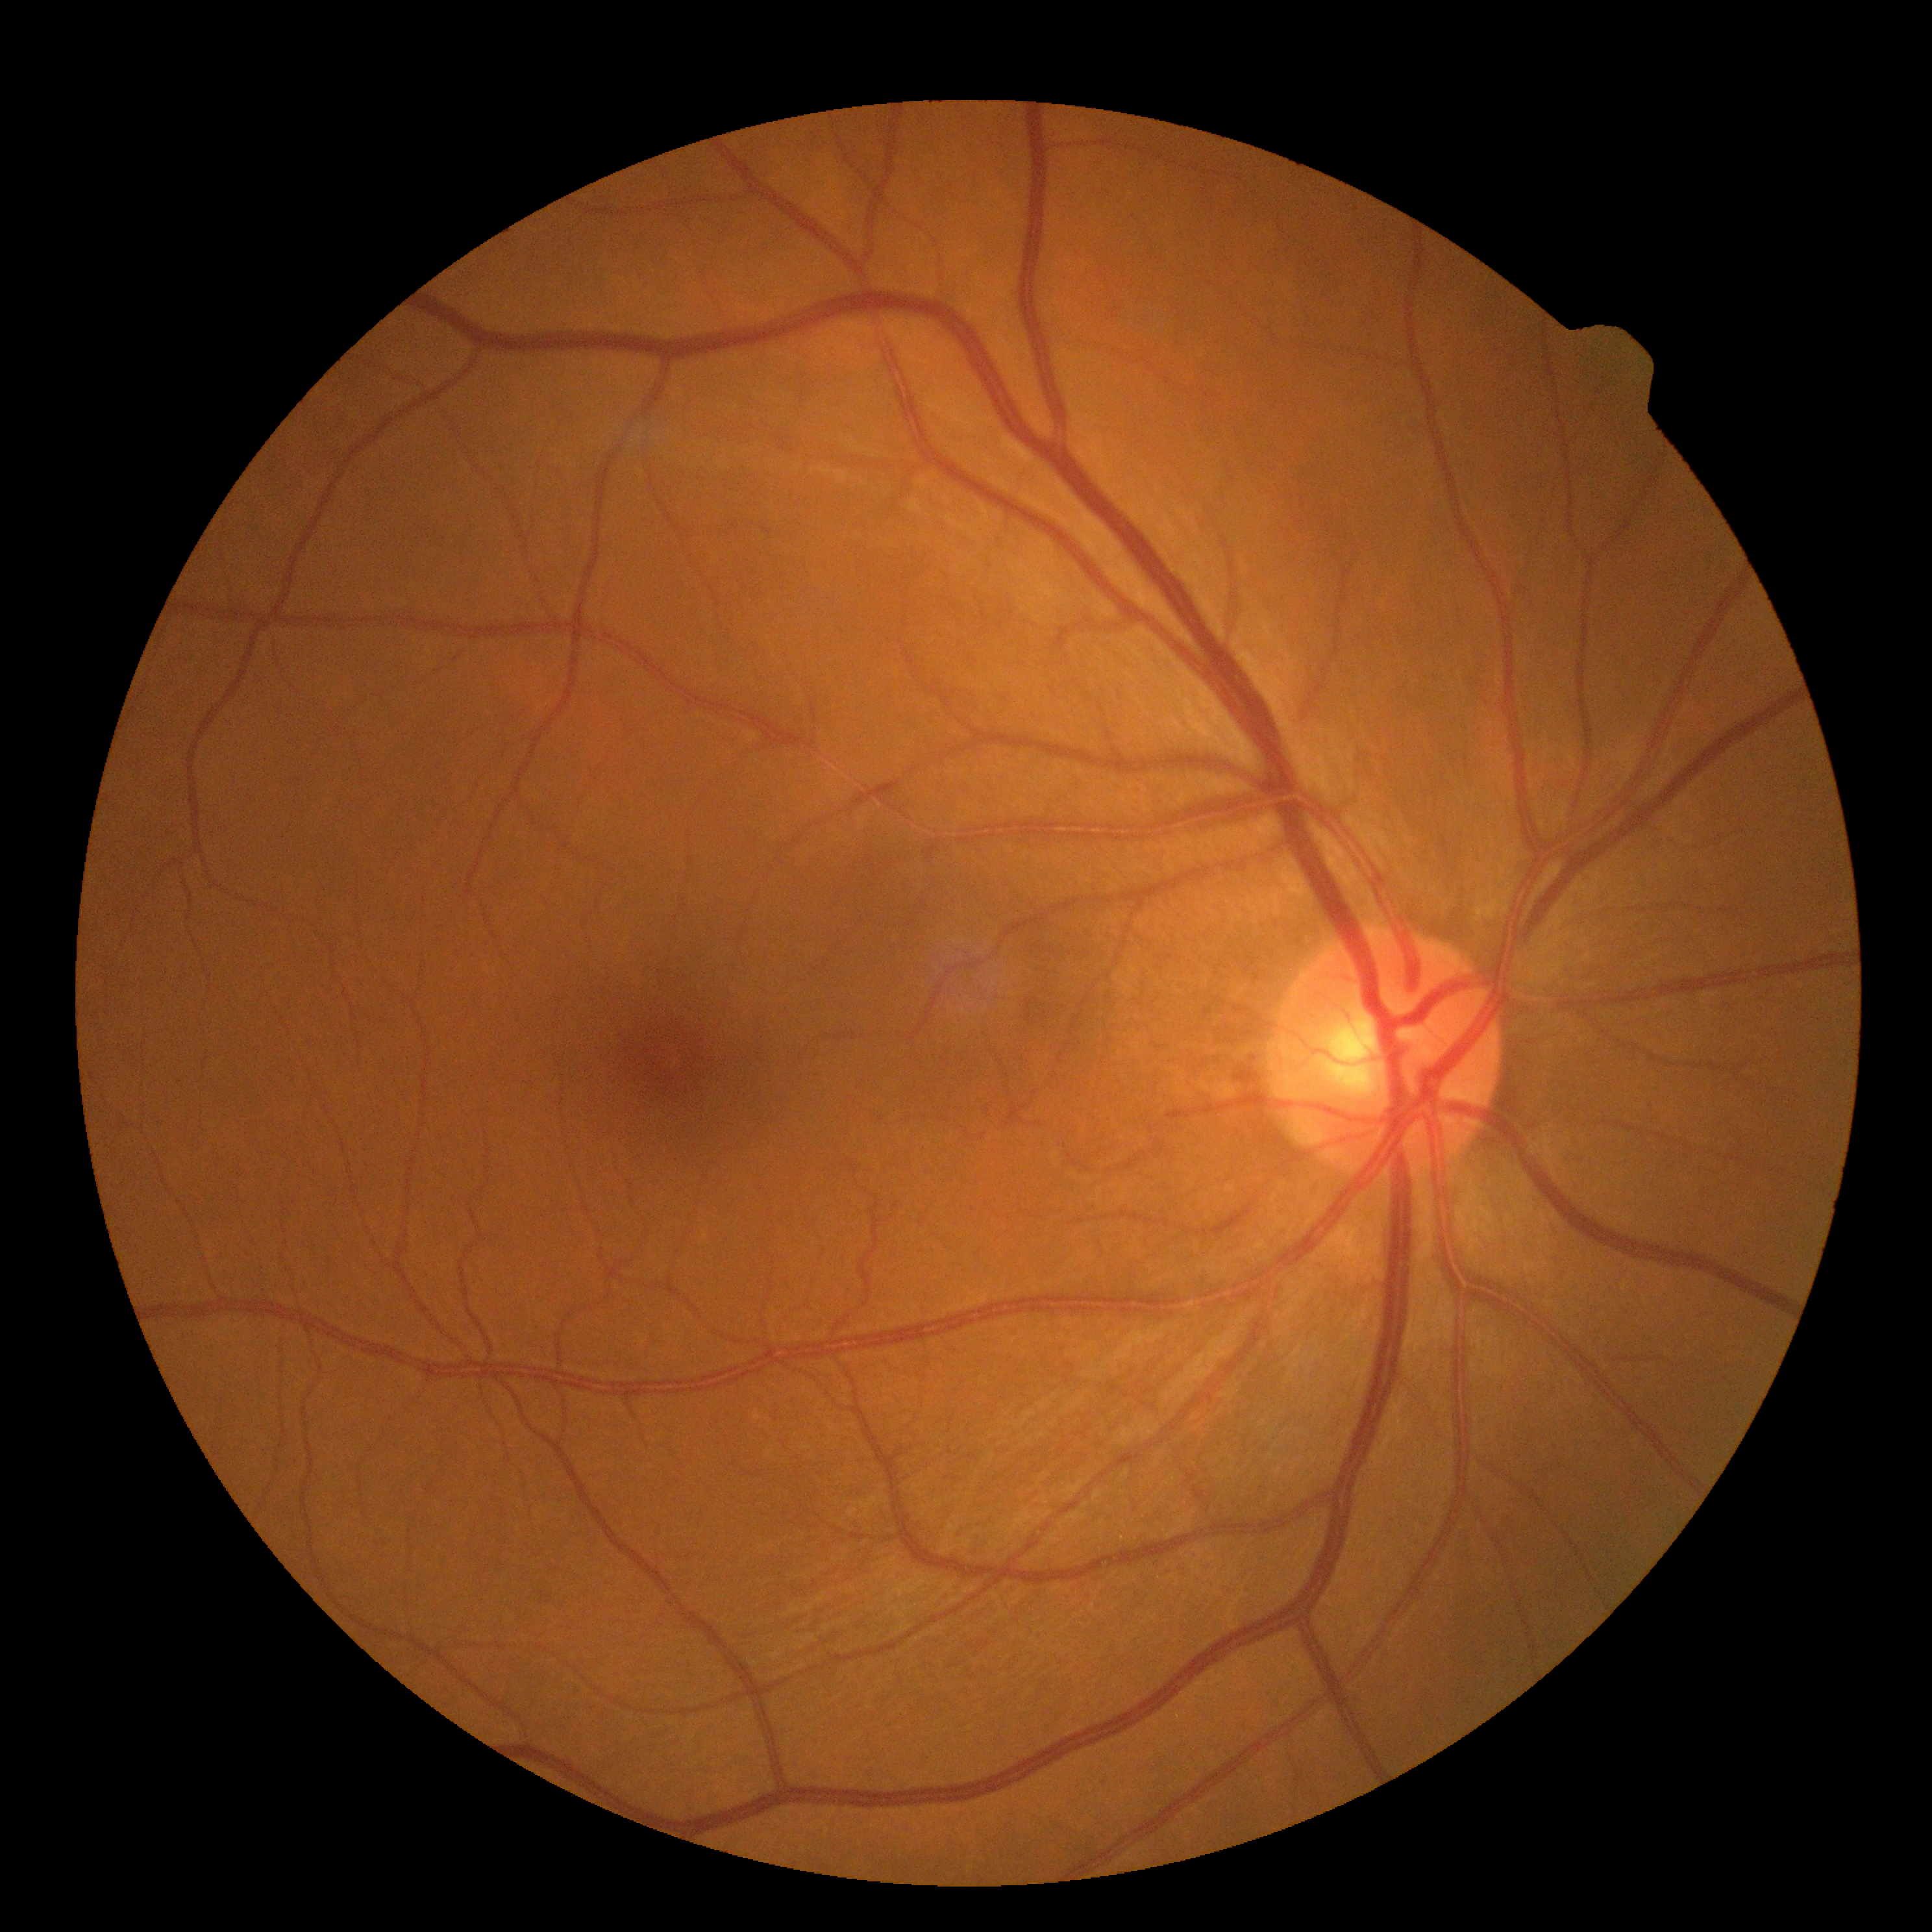

diabetic retinopathy: no apparent retinopathy (grade 0).